Wide-field fundus image from infant ROP screening. 640 x 480 pixels. 130° field of view (Clarity RetCam 3): 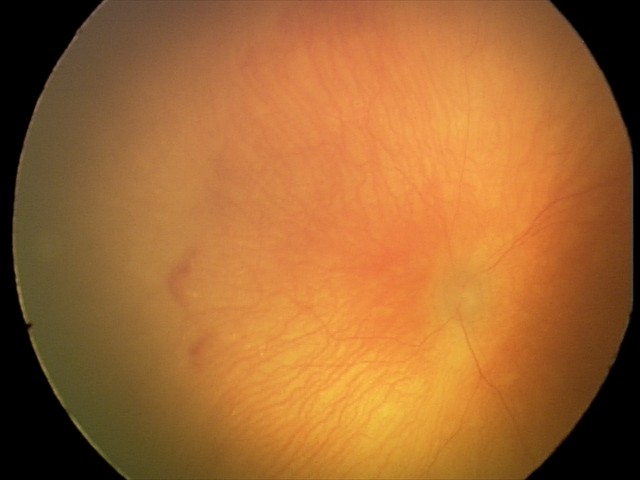
Screening series with aggressive retinopathy of prematurity (A-ROP).